1932 x 1932 pixels; 45° FOV: 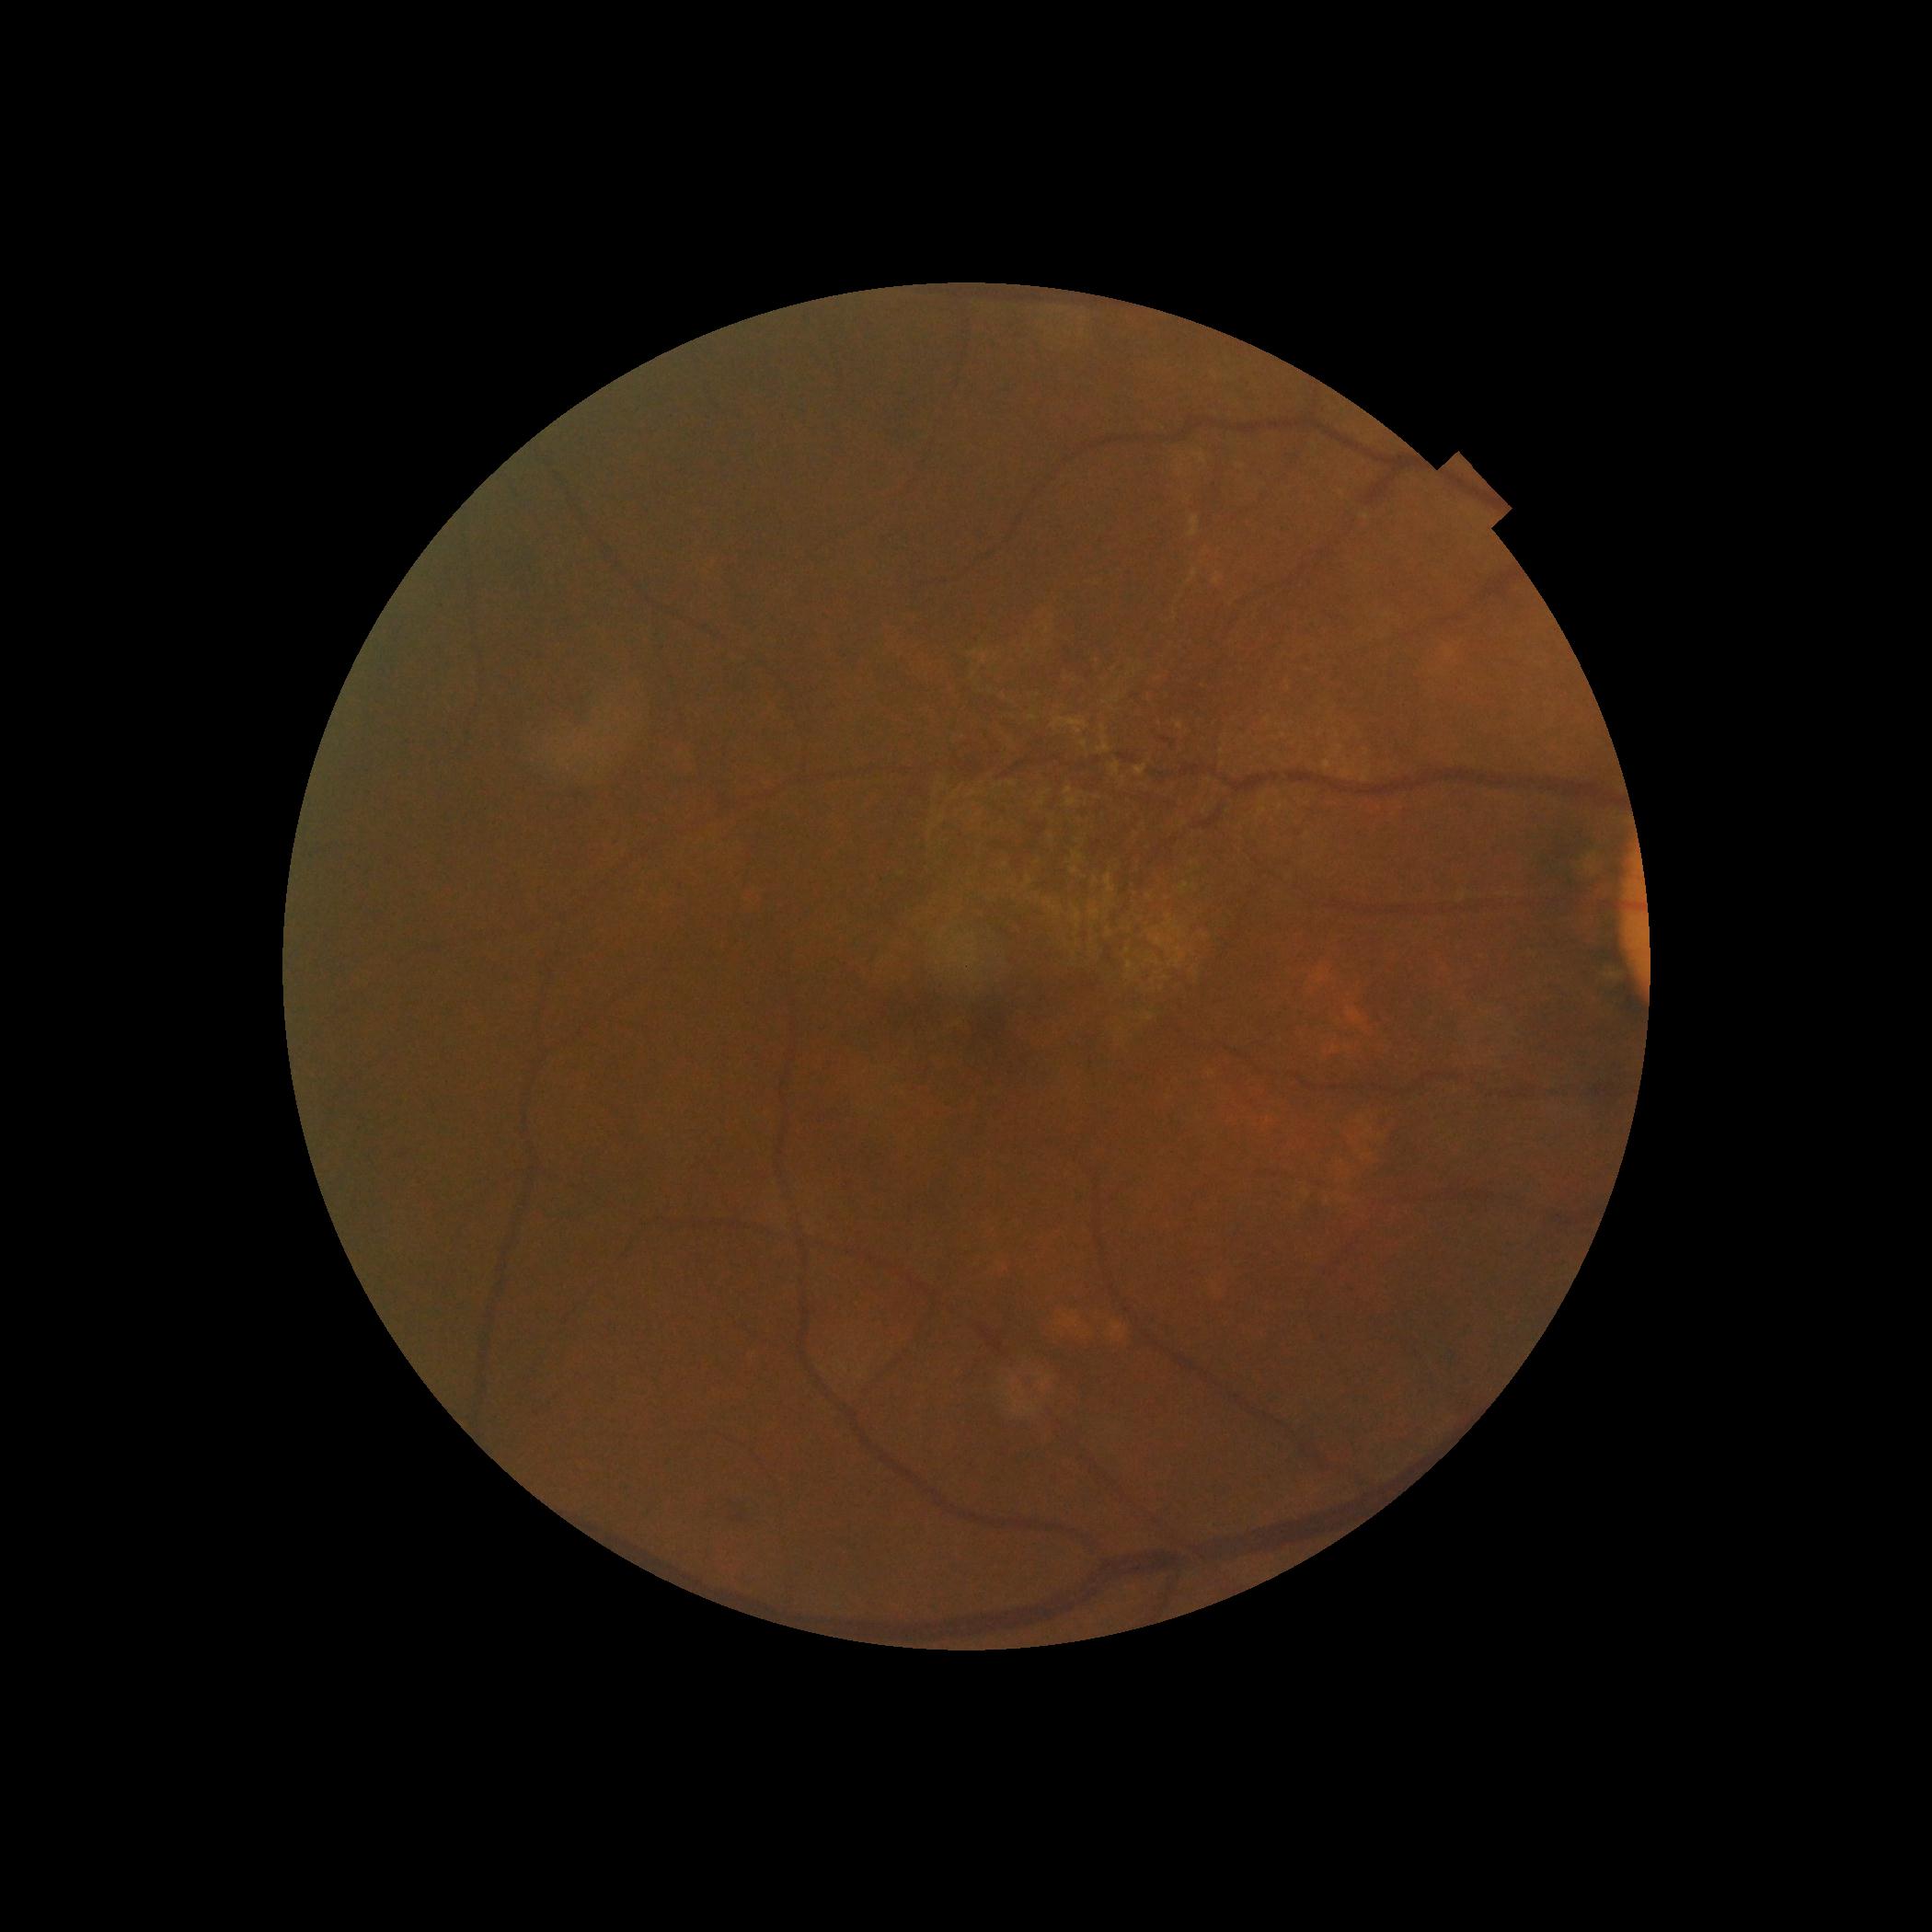
Retinopathy grade is moderate NPDR (2) — more than just microaneurysms but less than severe NPDR. DR class: non-proliferative diabetic retinopathy.